NIDEK AFC-230 fundus camera. 848 by 848 pixels: 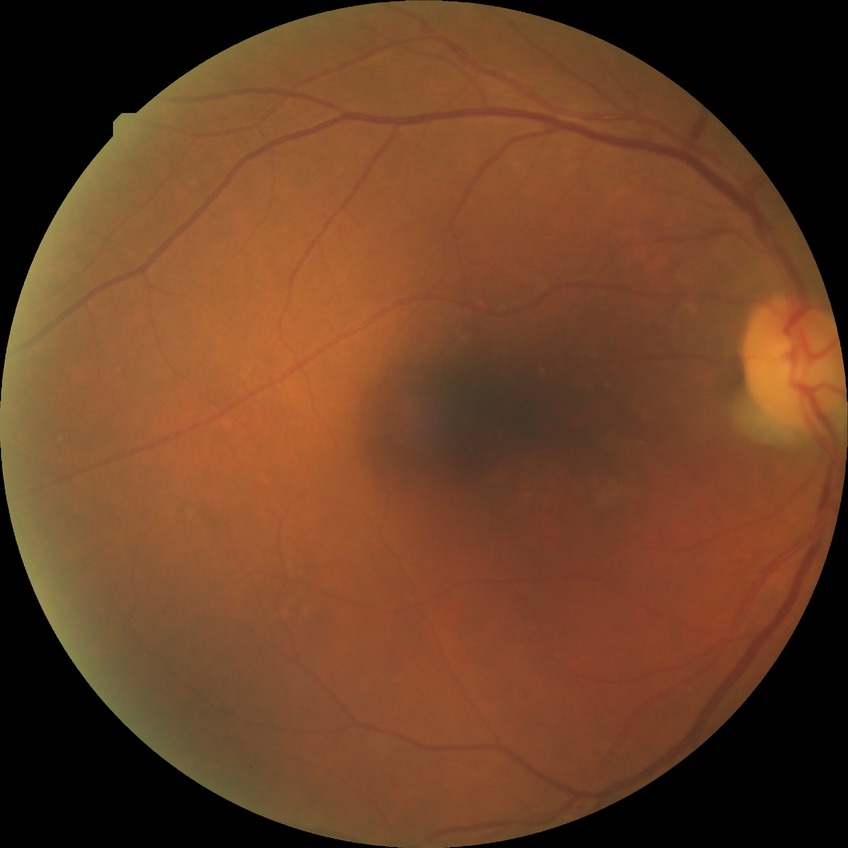 {
  "davis_grade": "NDR (no diabetic retinopathy)"
}